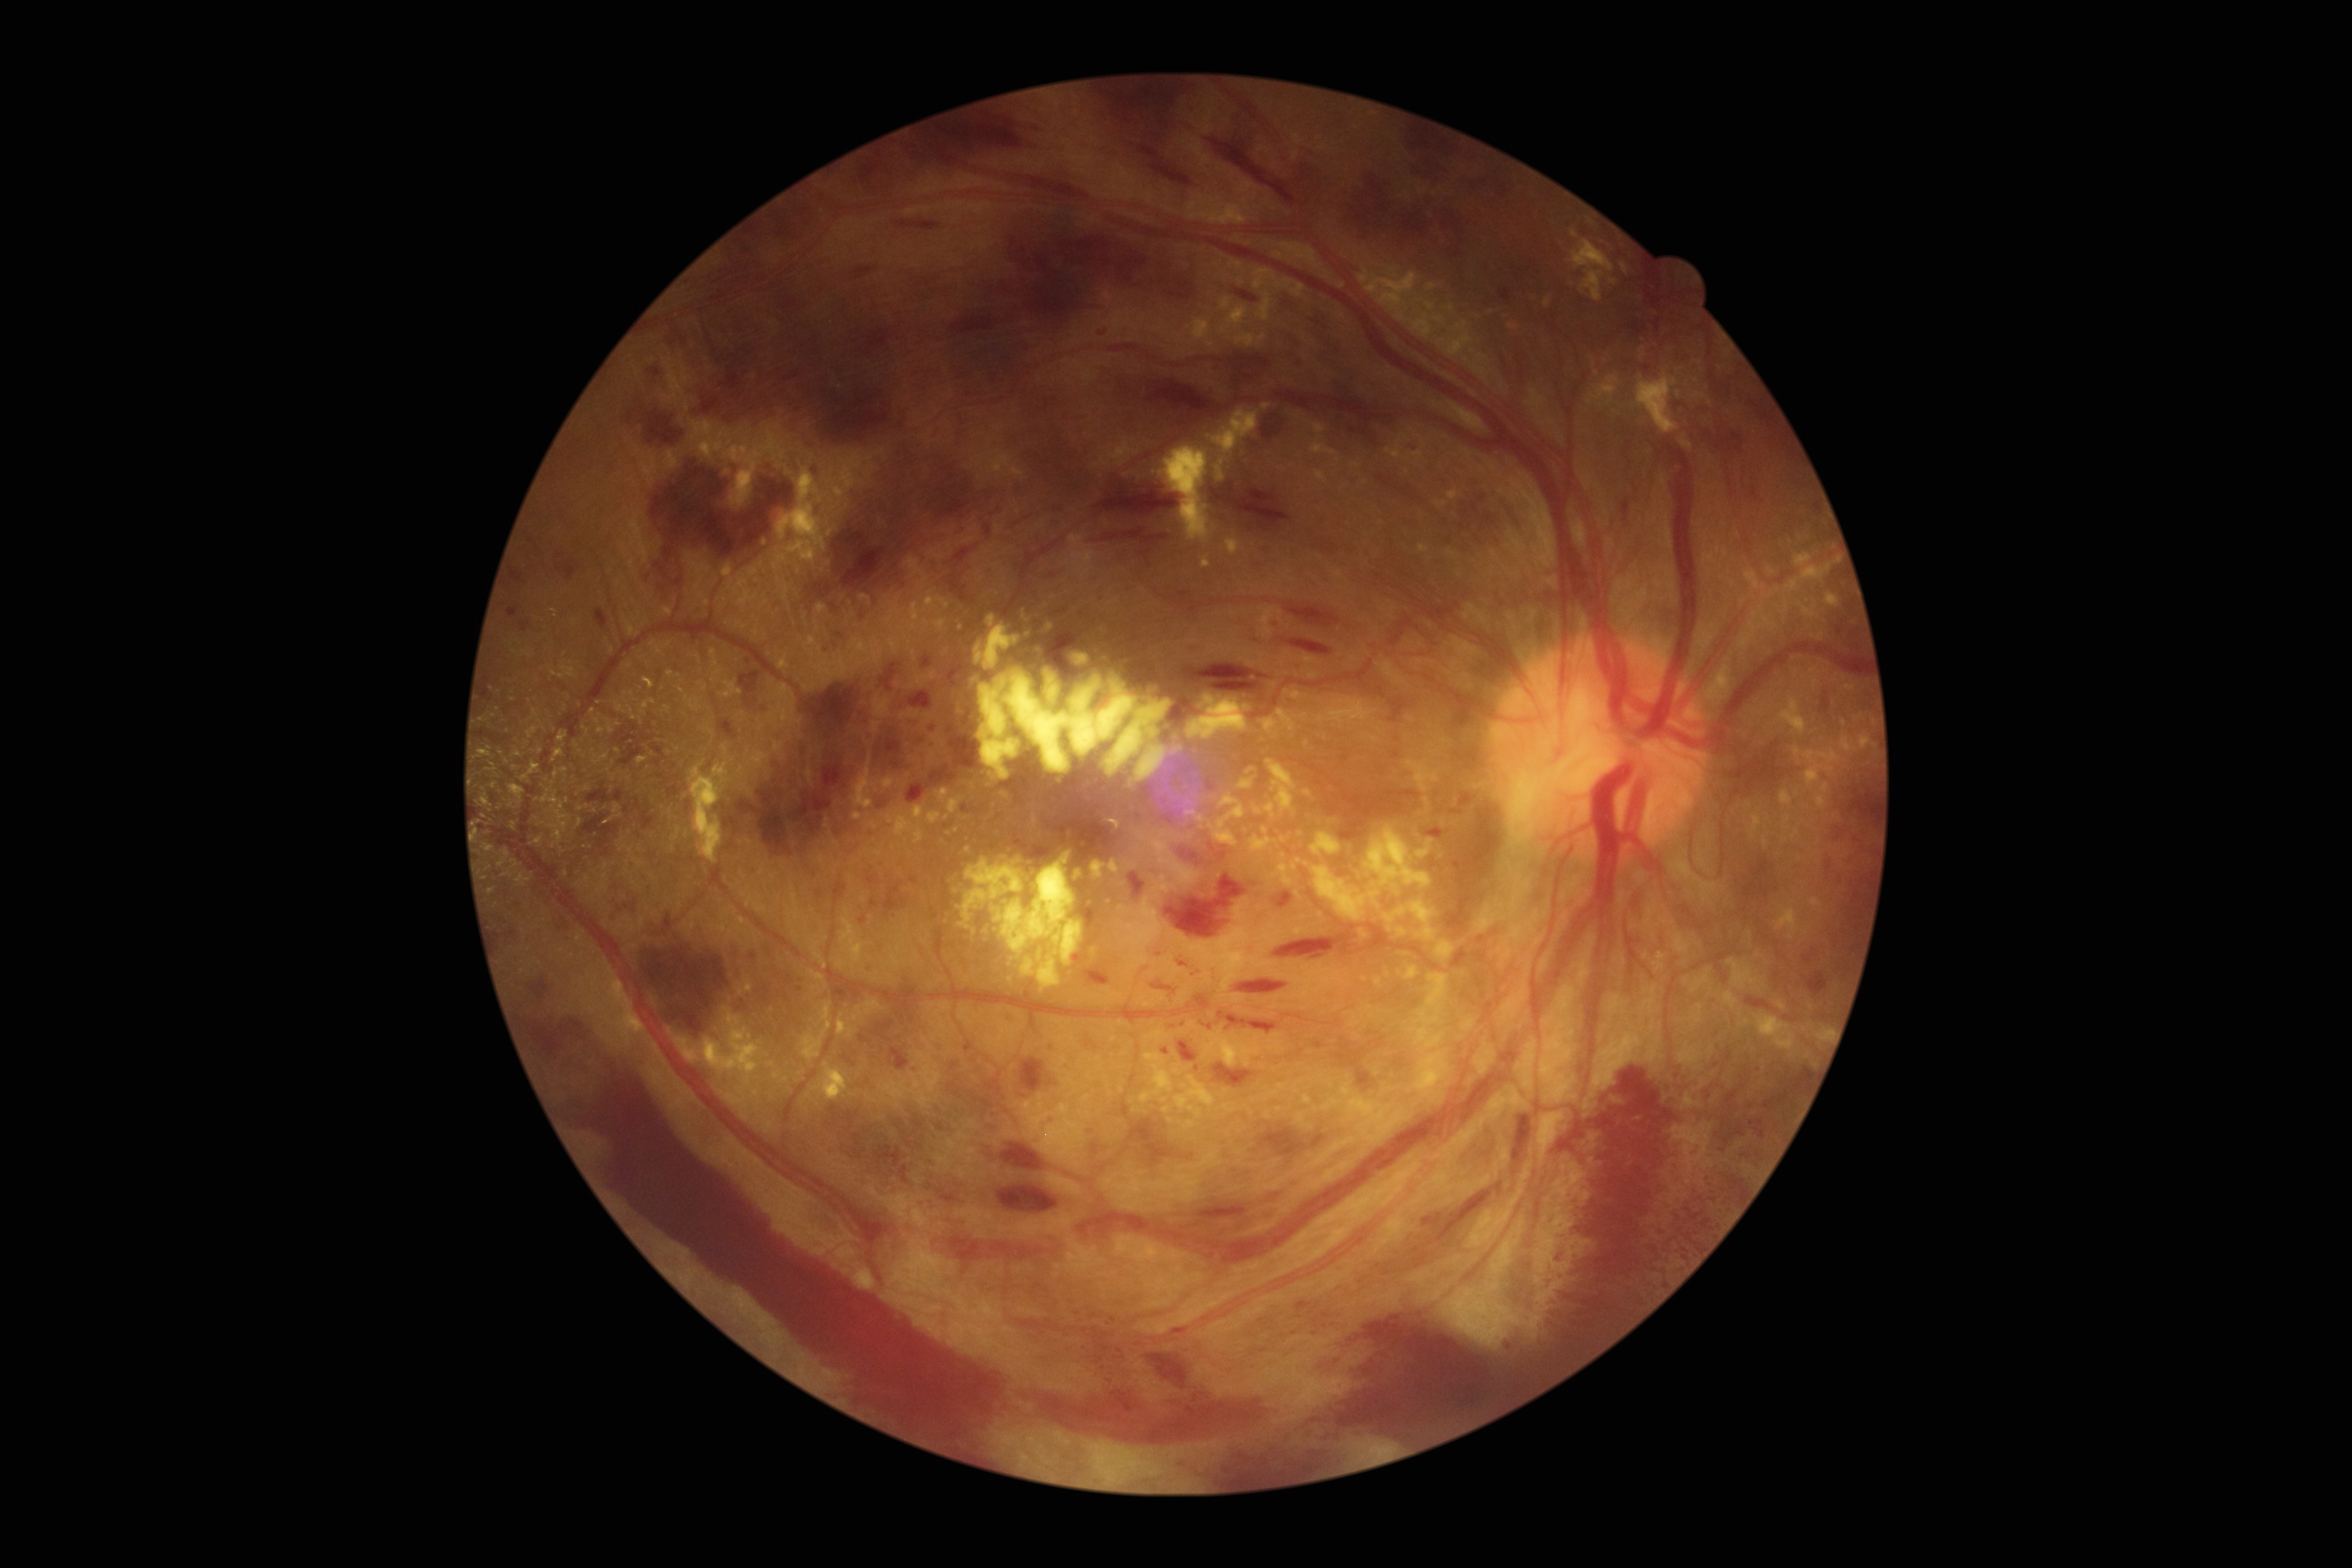
Diabetic retinopathy (DR): 4.